Color fundus image
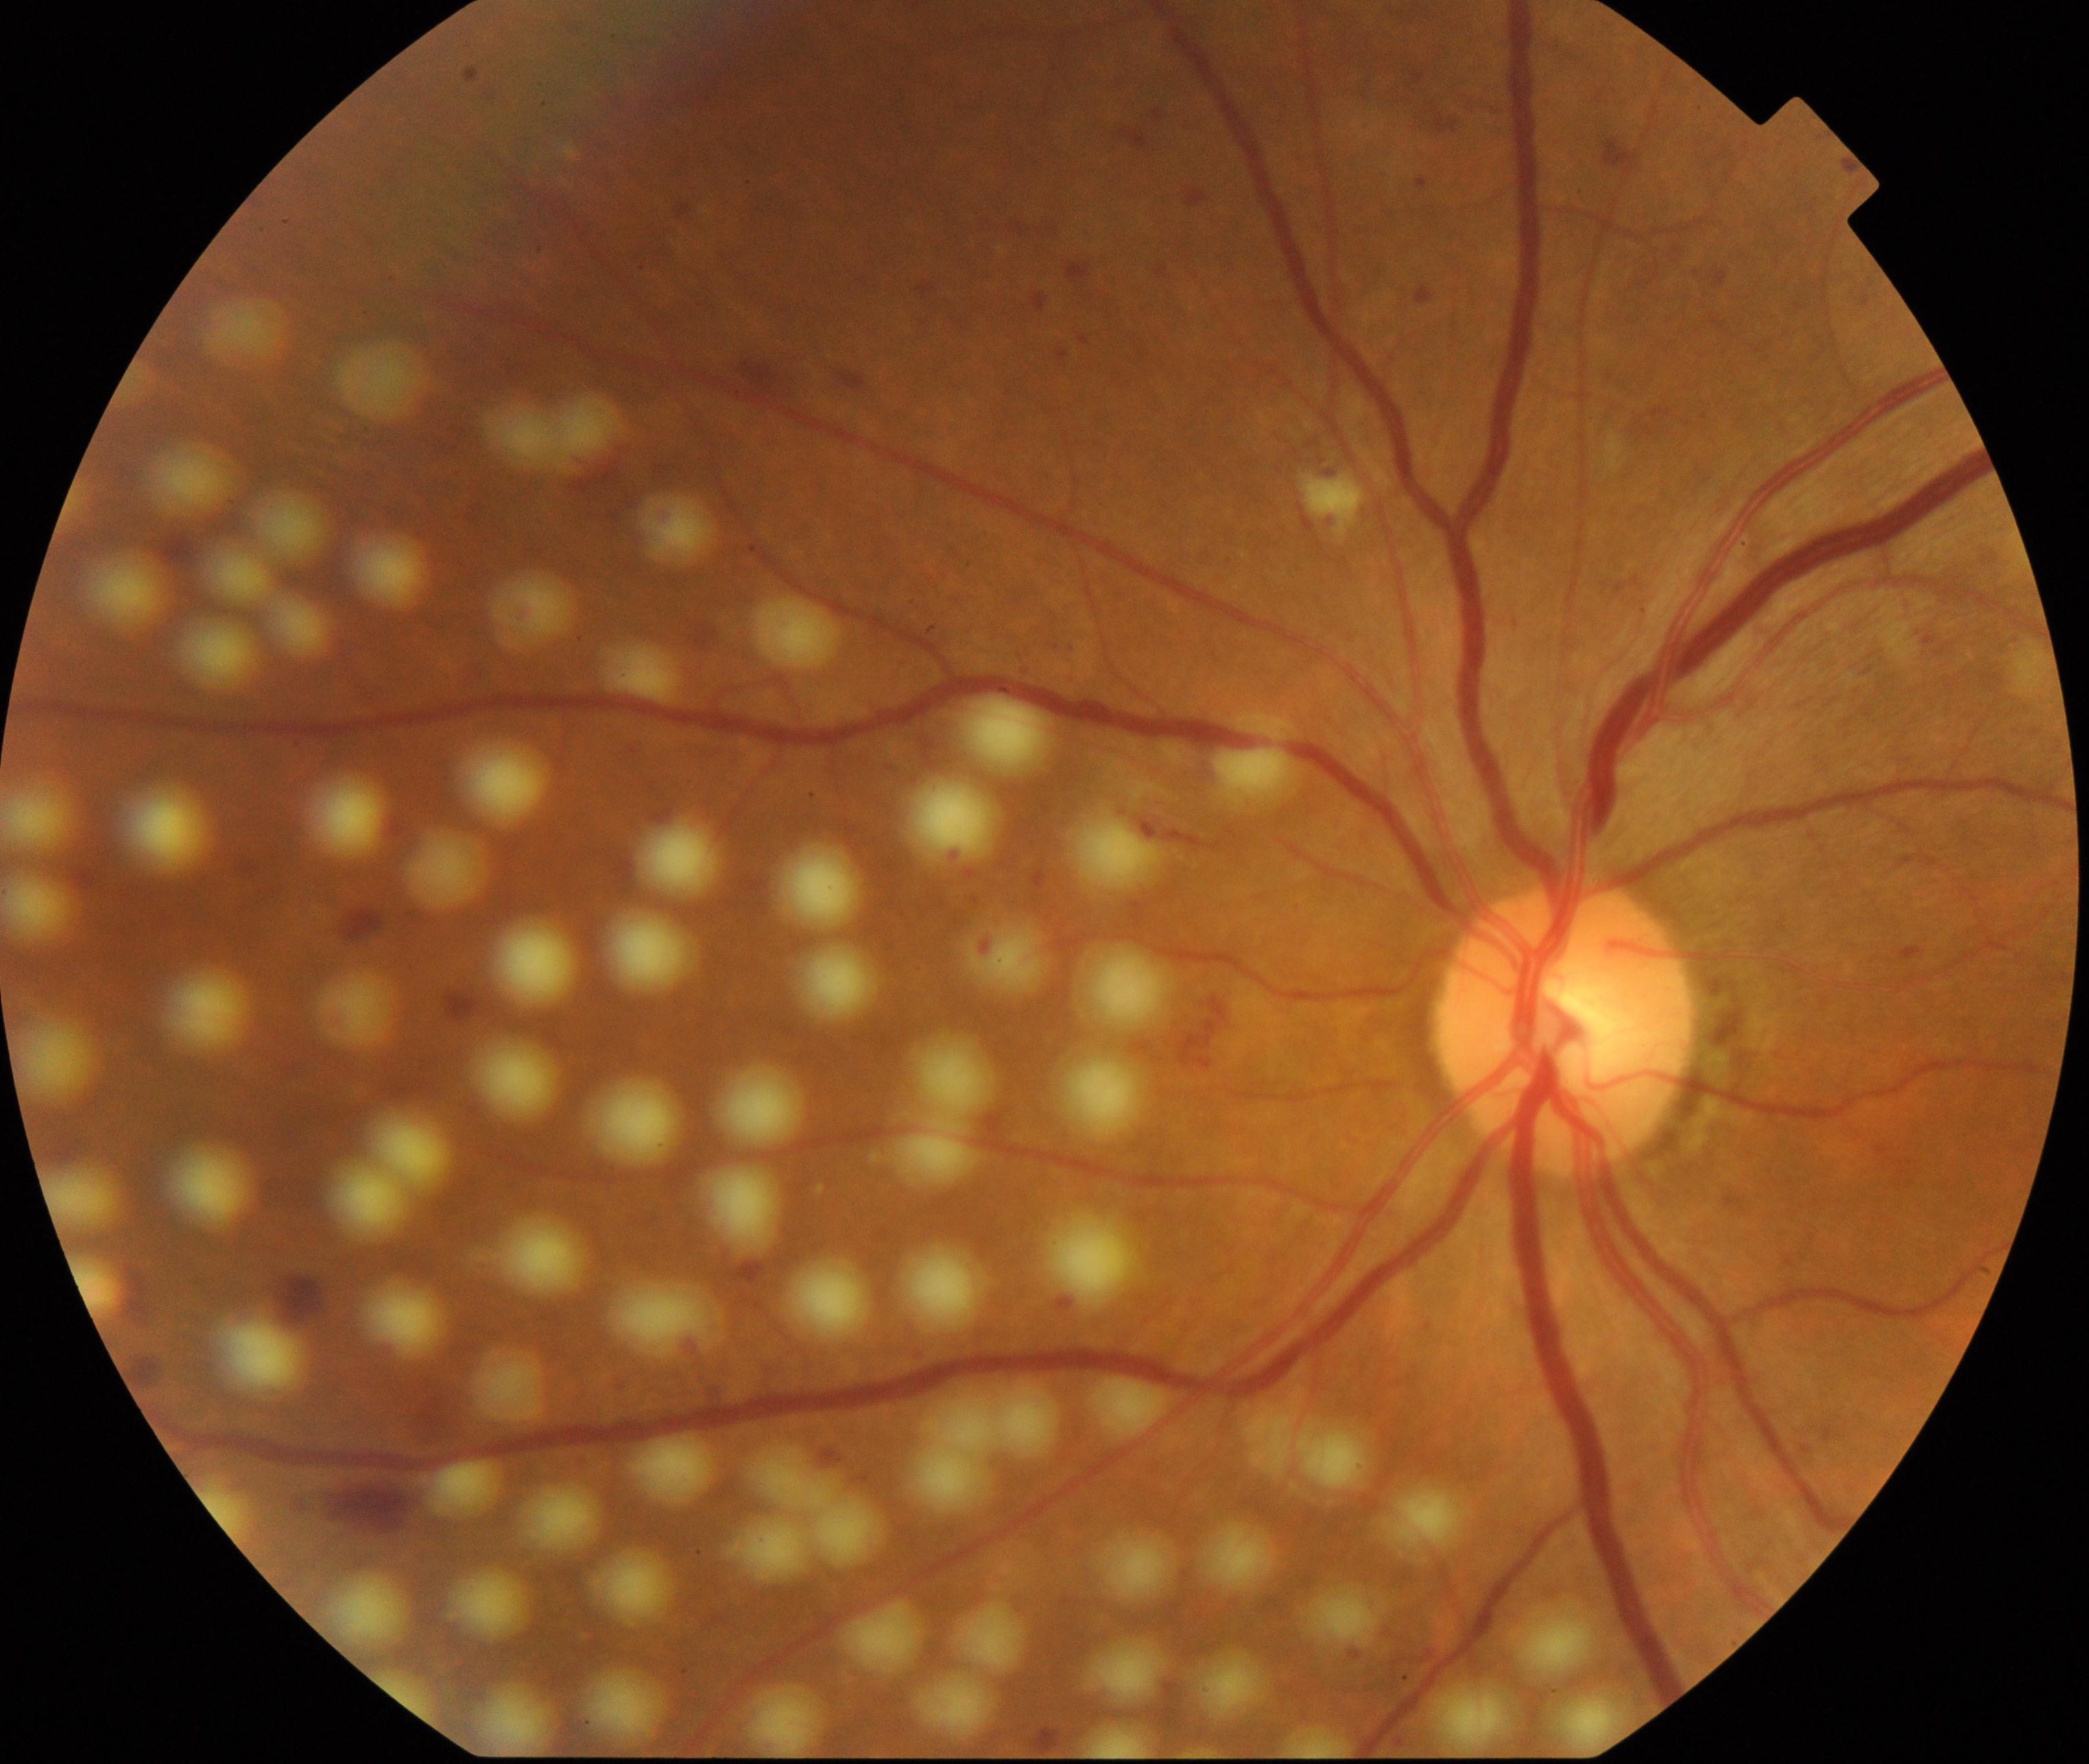
Impression: laser spots.